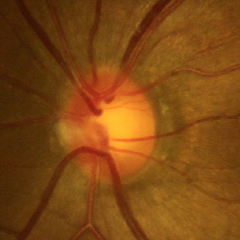
Glaucoma status: no glaucomatous findings.